100° field of view (Phoenix ICON) · wide-field fundus photograph from neonatal ROP screening
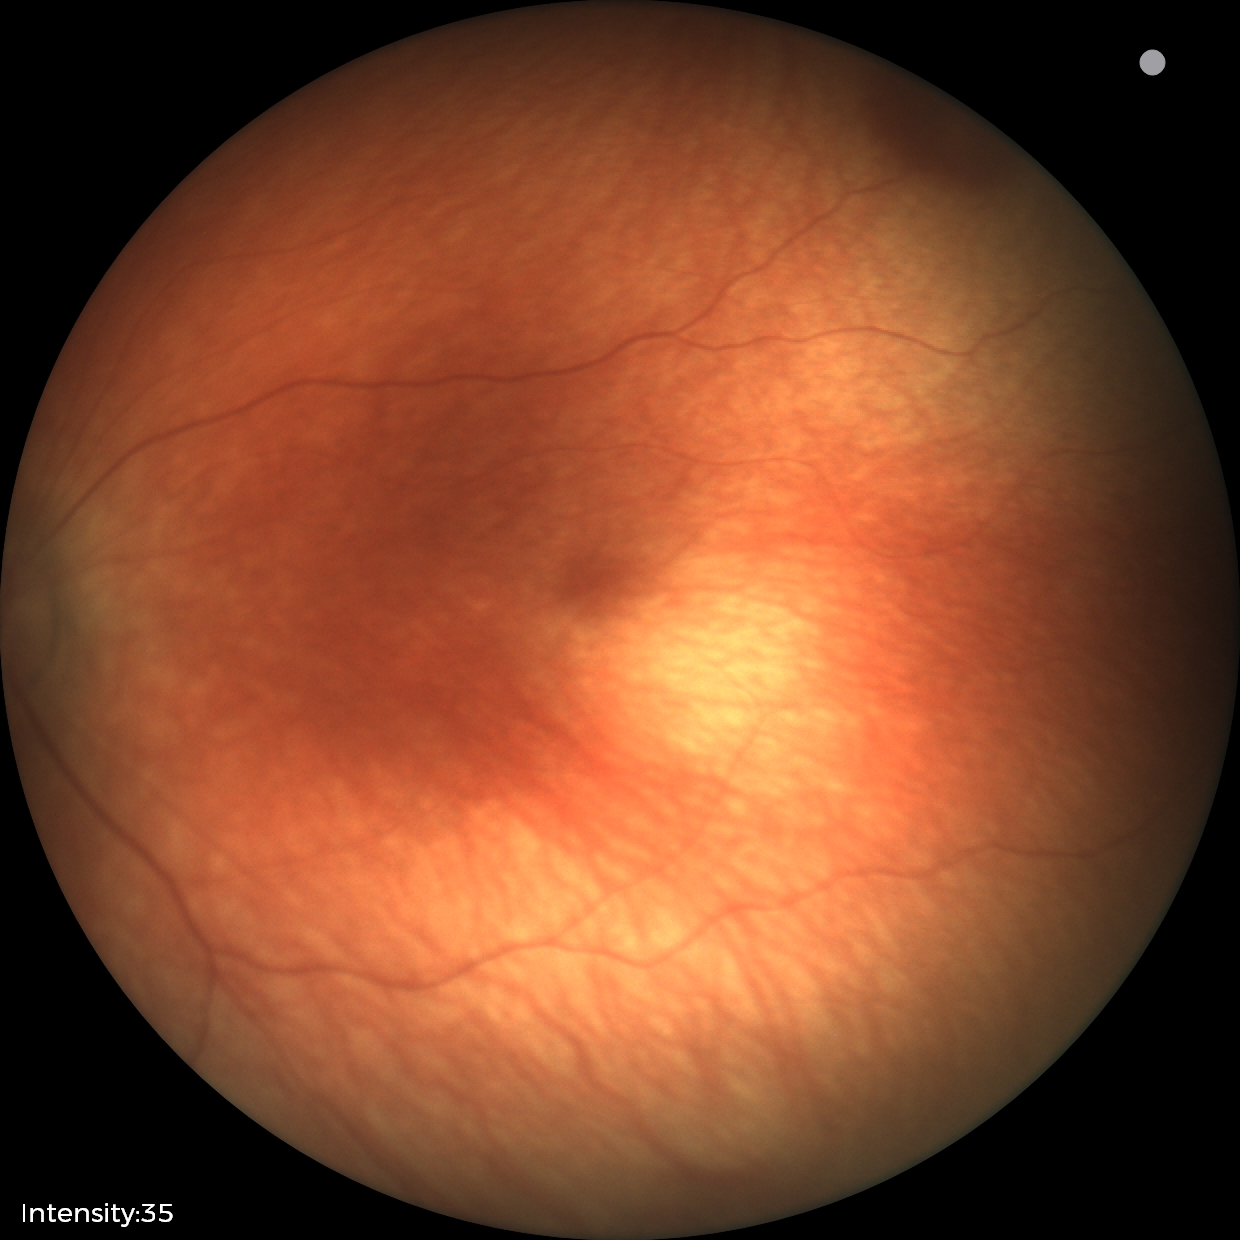 Series diagnosed as retinal hemorrhages.